Wide-field fundus photograph from neonatal ROP screening.
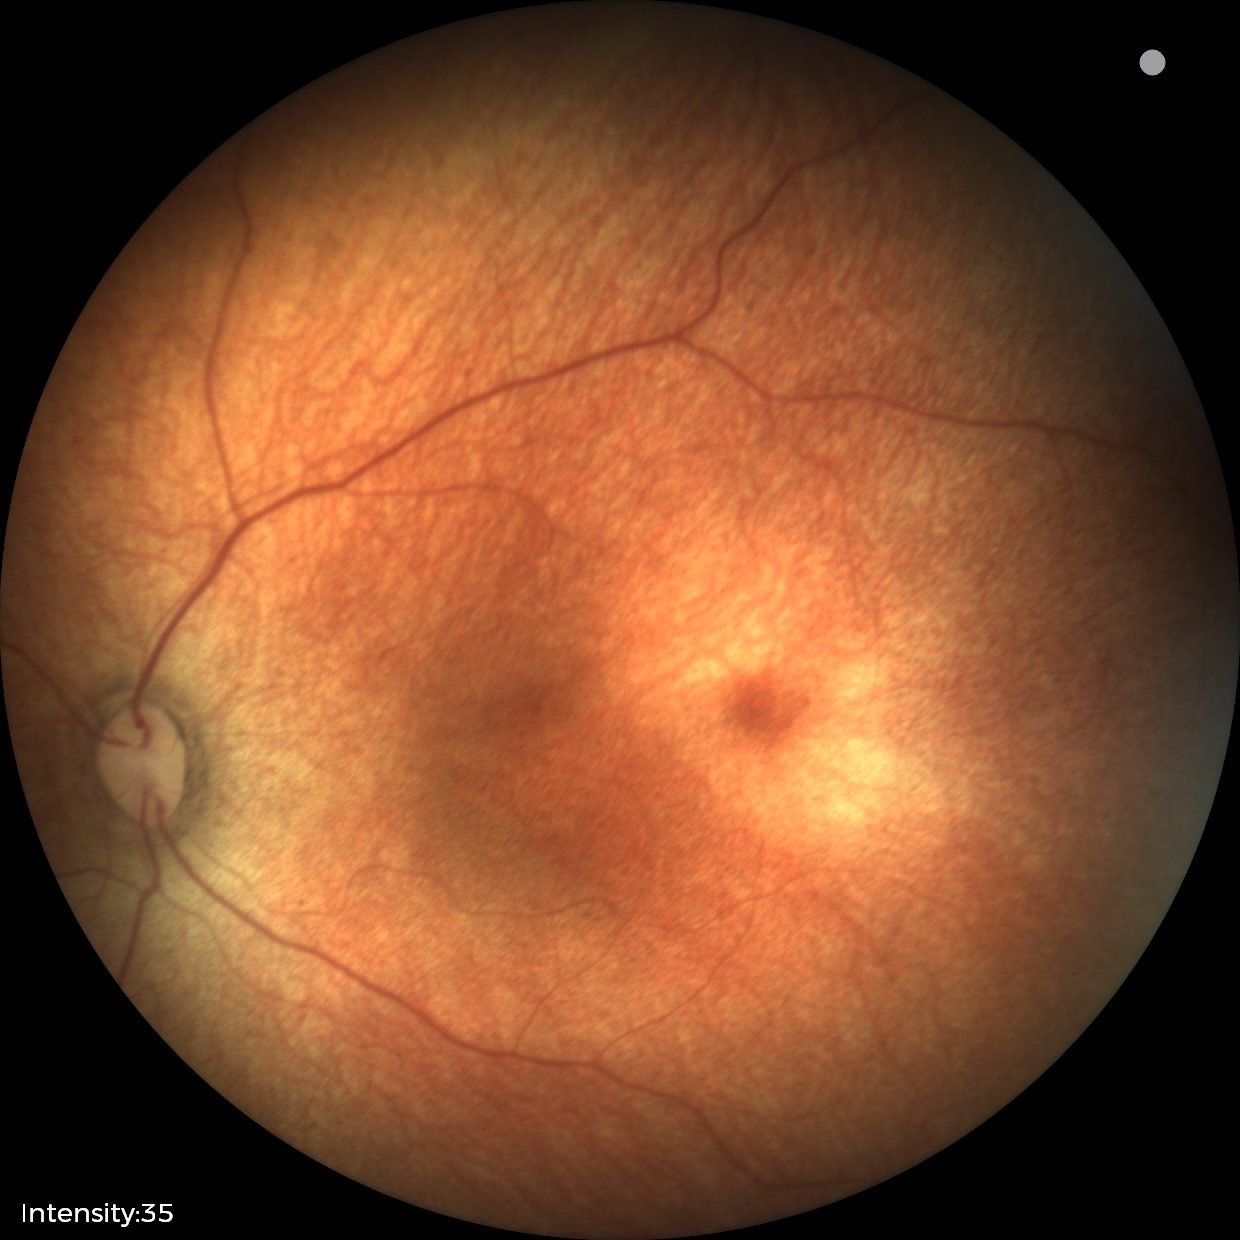 Physiological retinal appearance for postconceptual age.